Portable fundus photograph, 2212 by 1659 pixels — 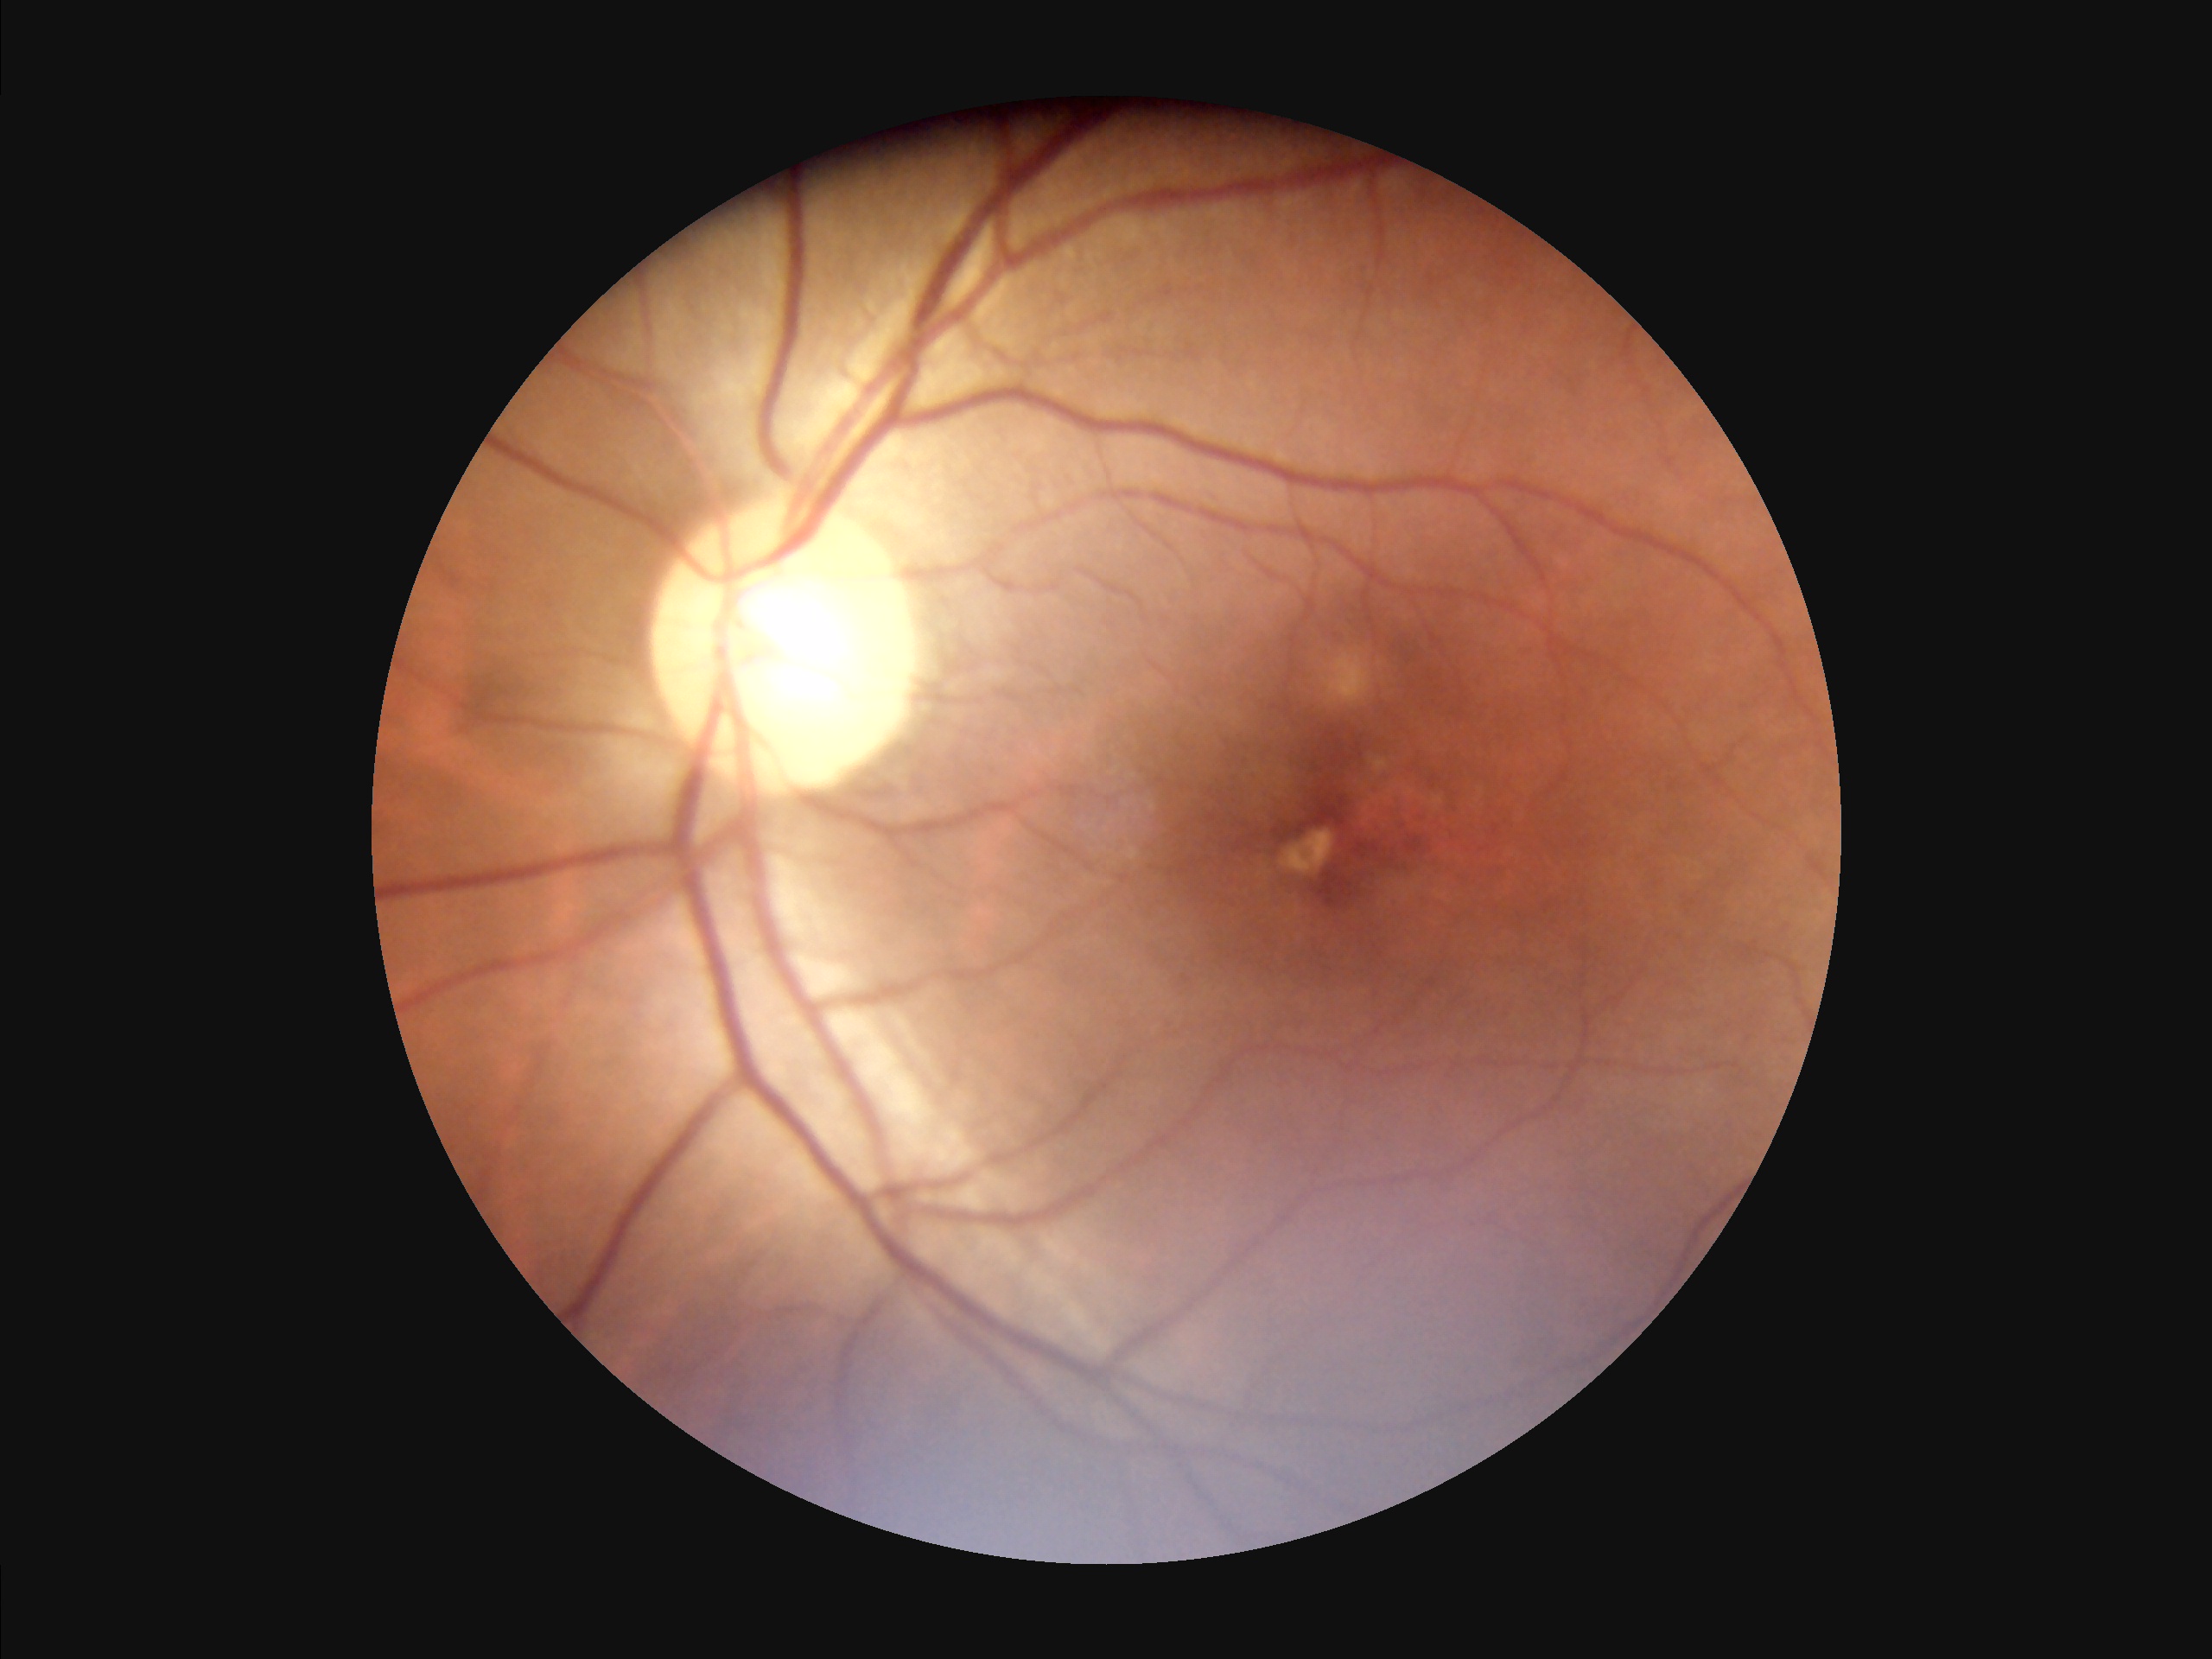 Contrast: adequate
Illumination/color: suboptimal
Sharpness: good
Overall: satisfactory